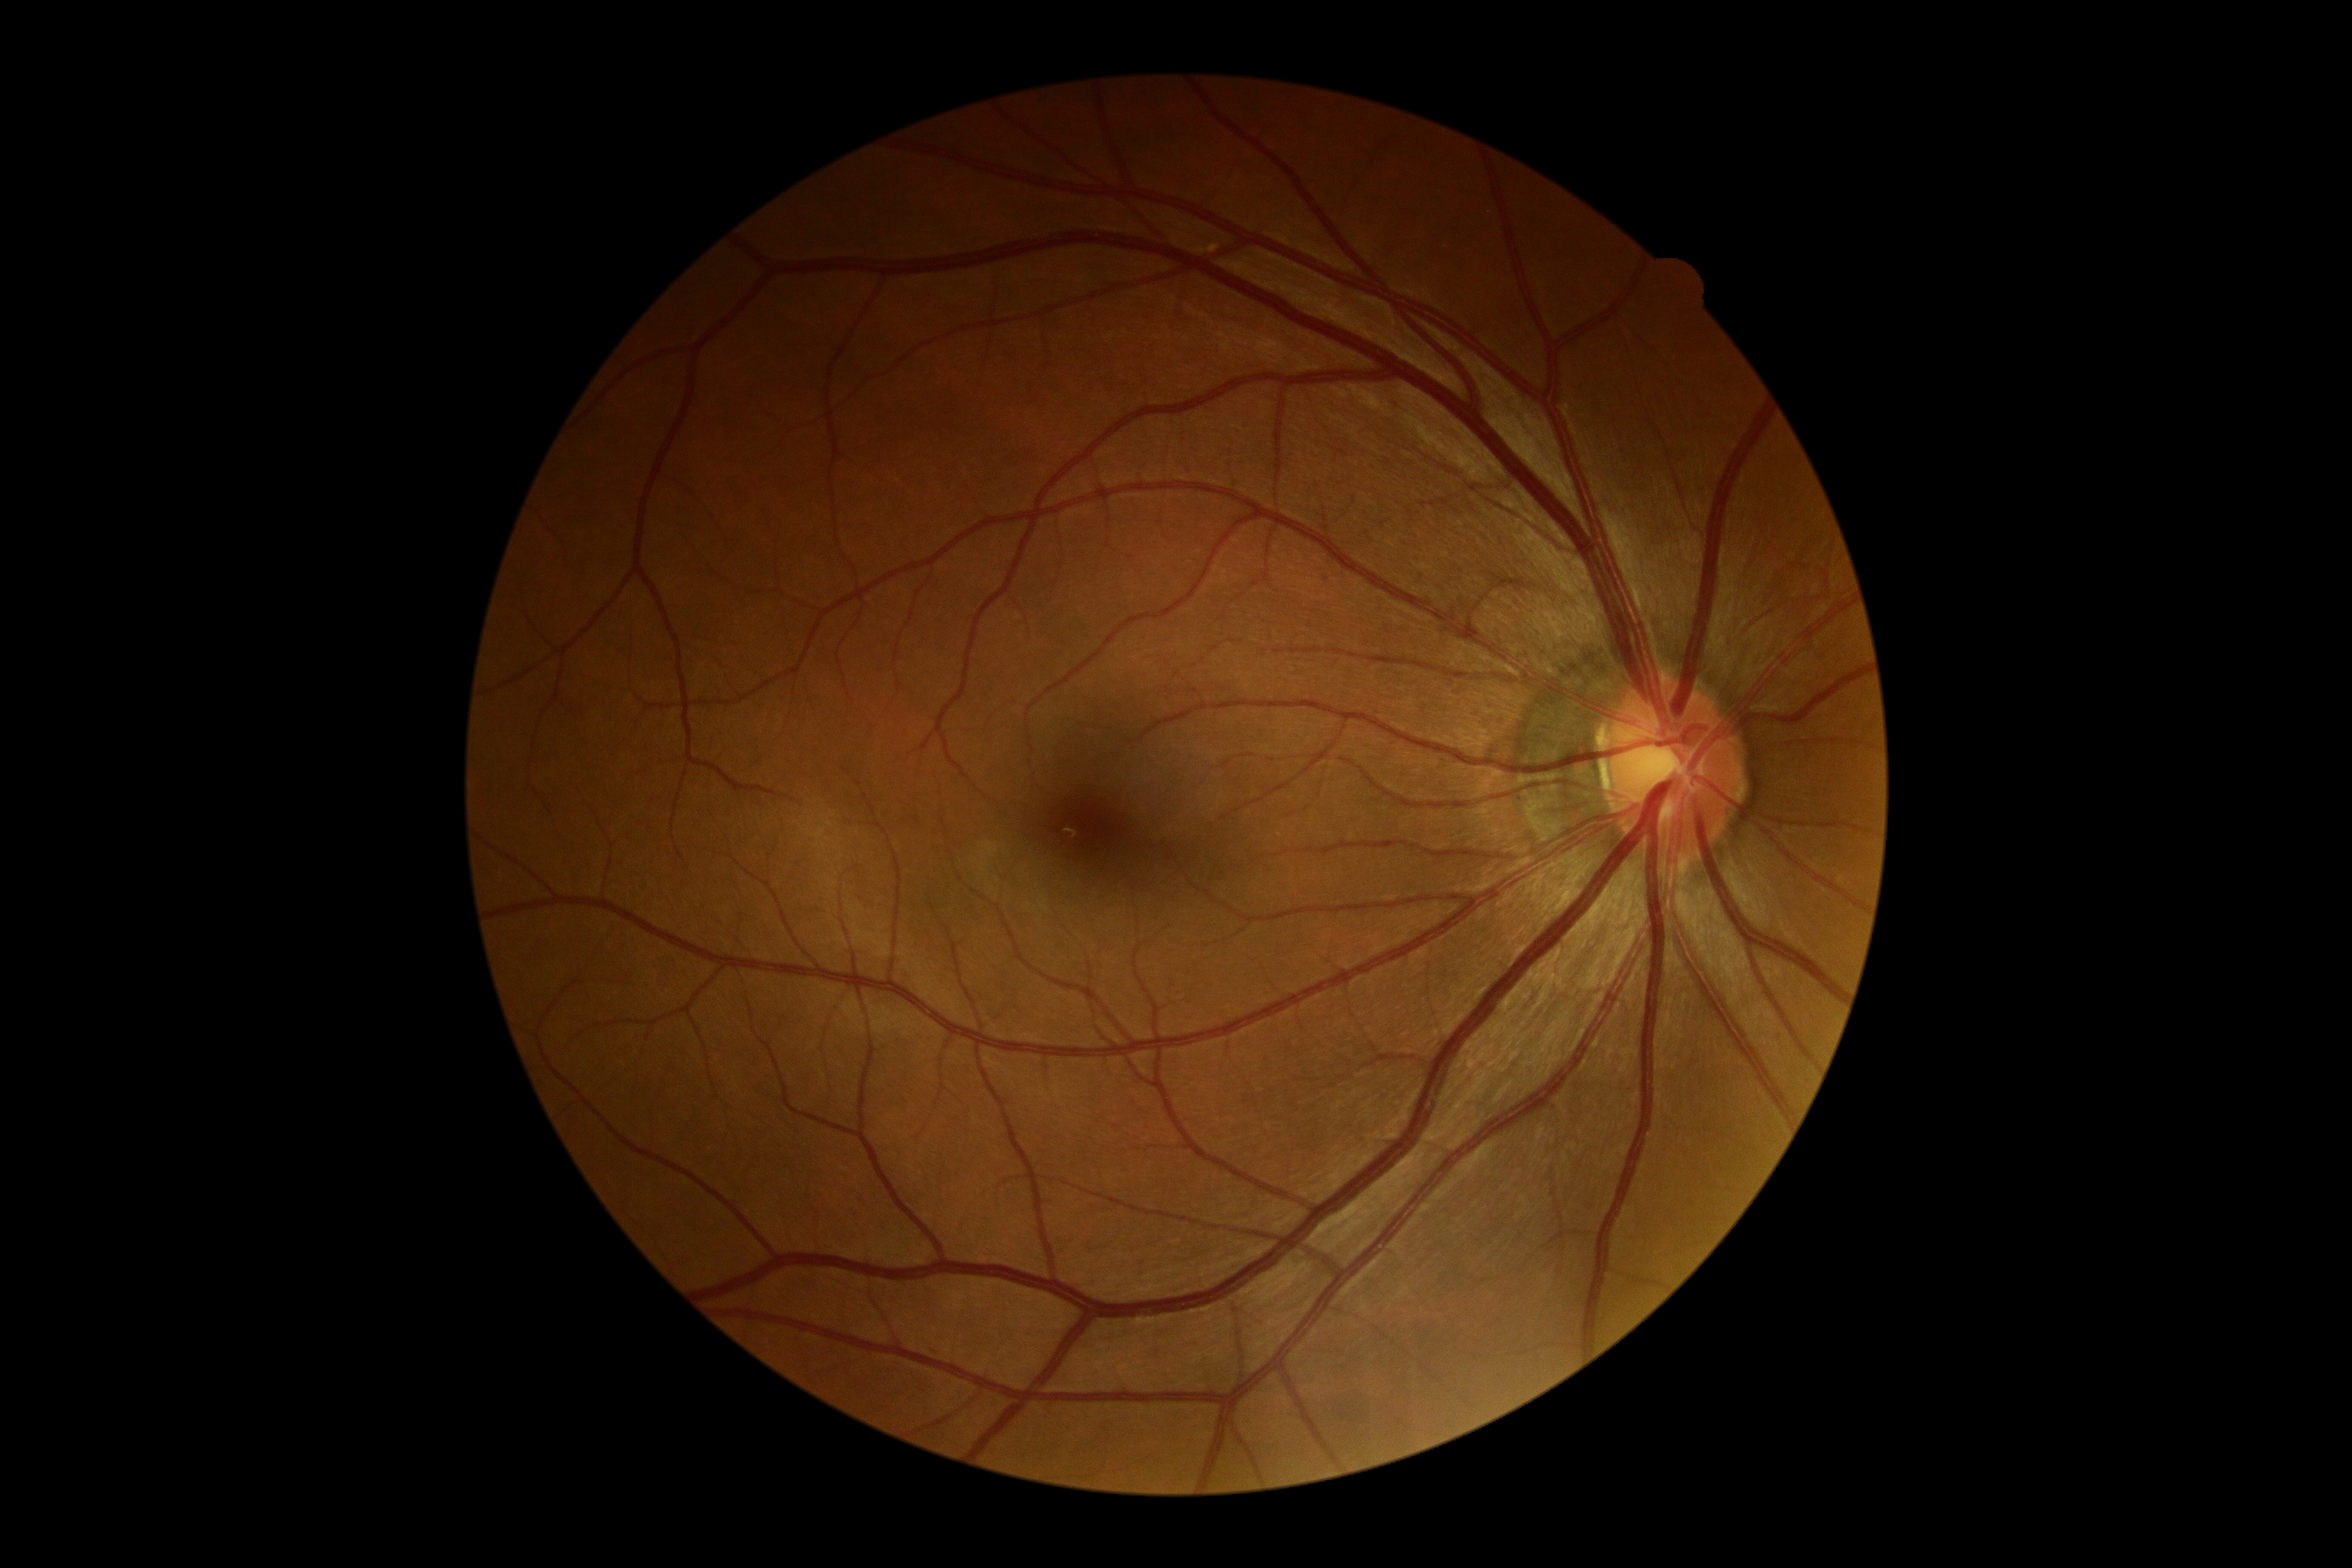
DR impression@no apparent DR; diabetic retinopathy@no apparent diabetic retinopathy (grade 0).